Camera: Clarity RetCam 3 (130° FOV); RetCam wide-field infant fundus image; 640 by 480 pixels: 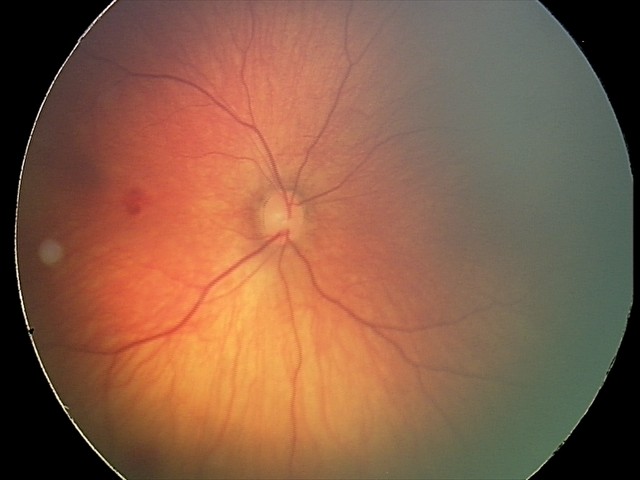
Series diagnosed as retinal hemorrhages.